512 x 512 pixels.
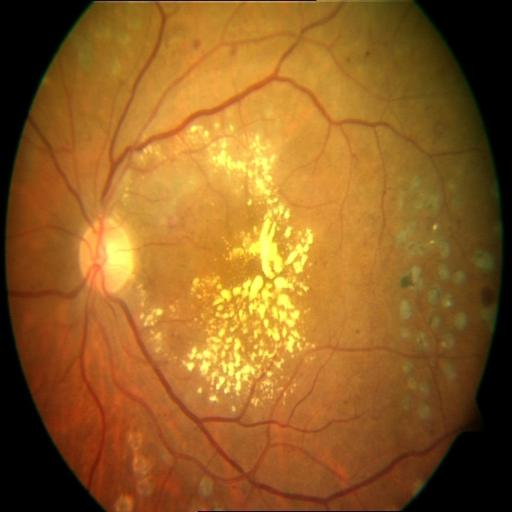
Retinal fundus photograph demonstrating laser scars, cystoid macular edema and exudation.